45-degree field of view. Image size 1932x1910.
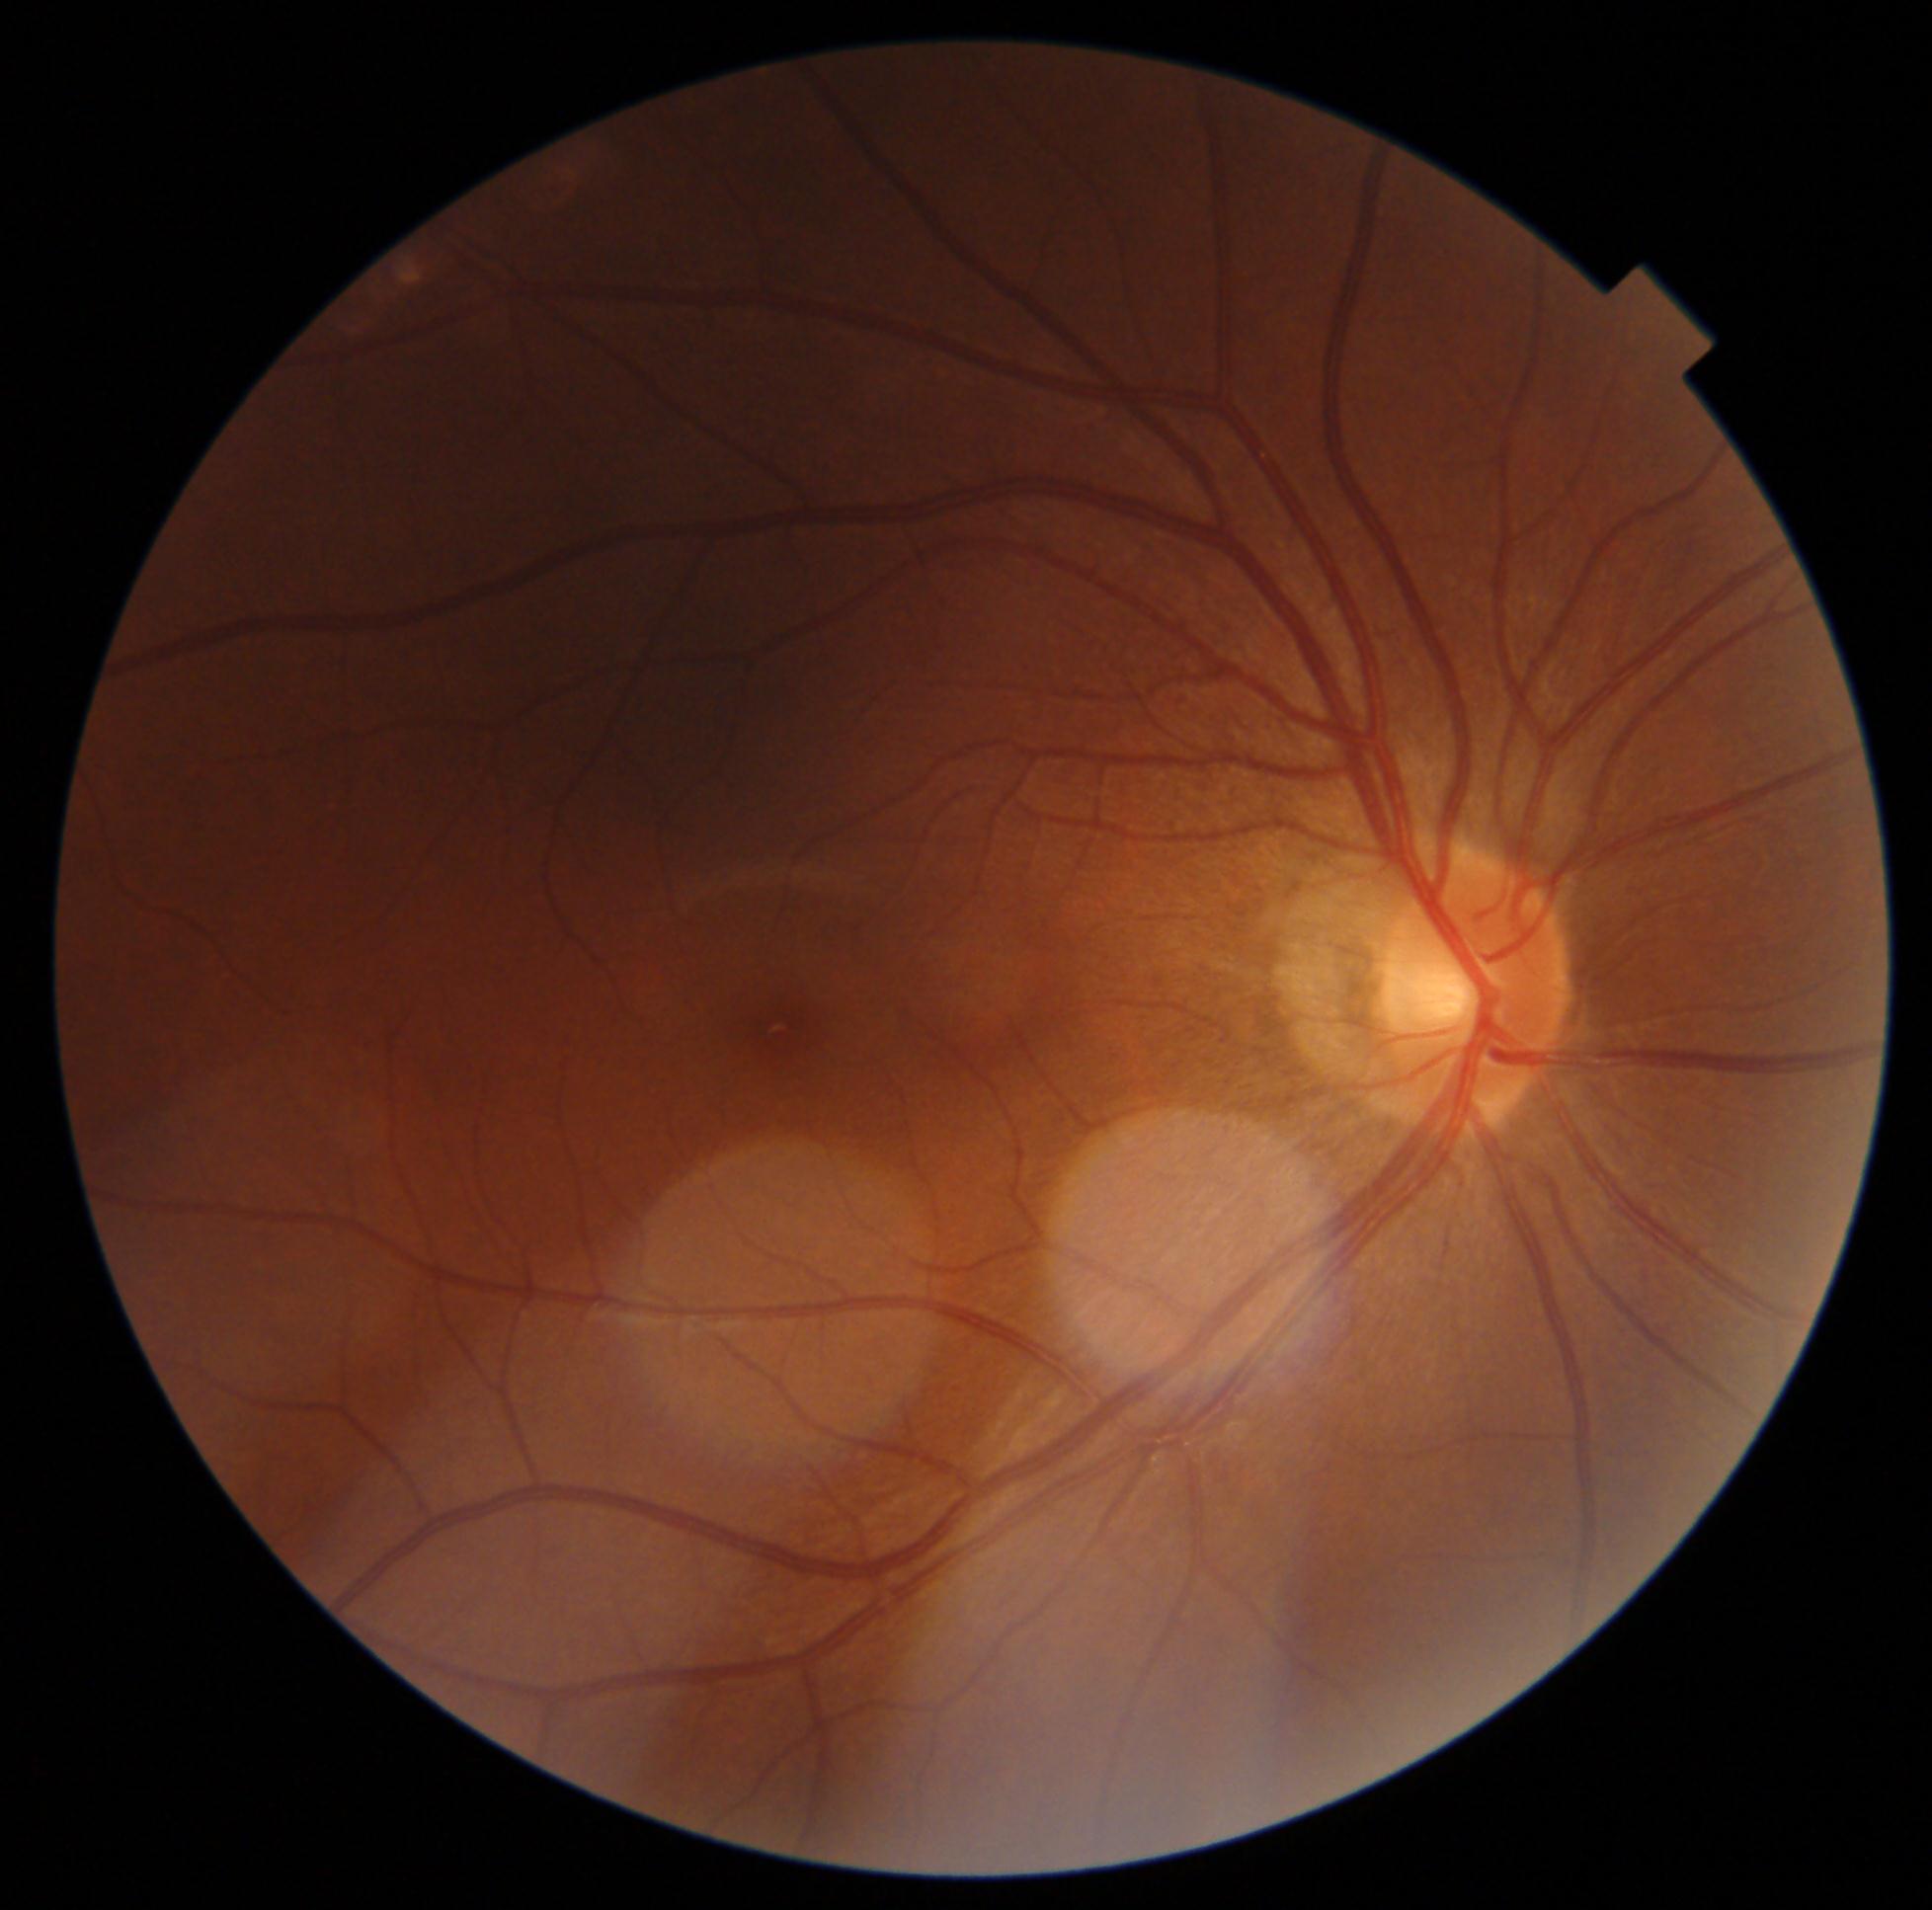

No diabetic retinal disease findings. DR severity: 0/4.